Retinal fundus photograph, 1932 by 1916 pixels
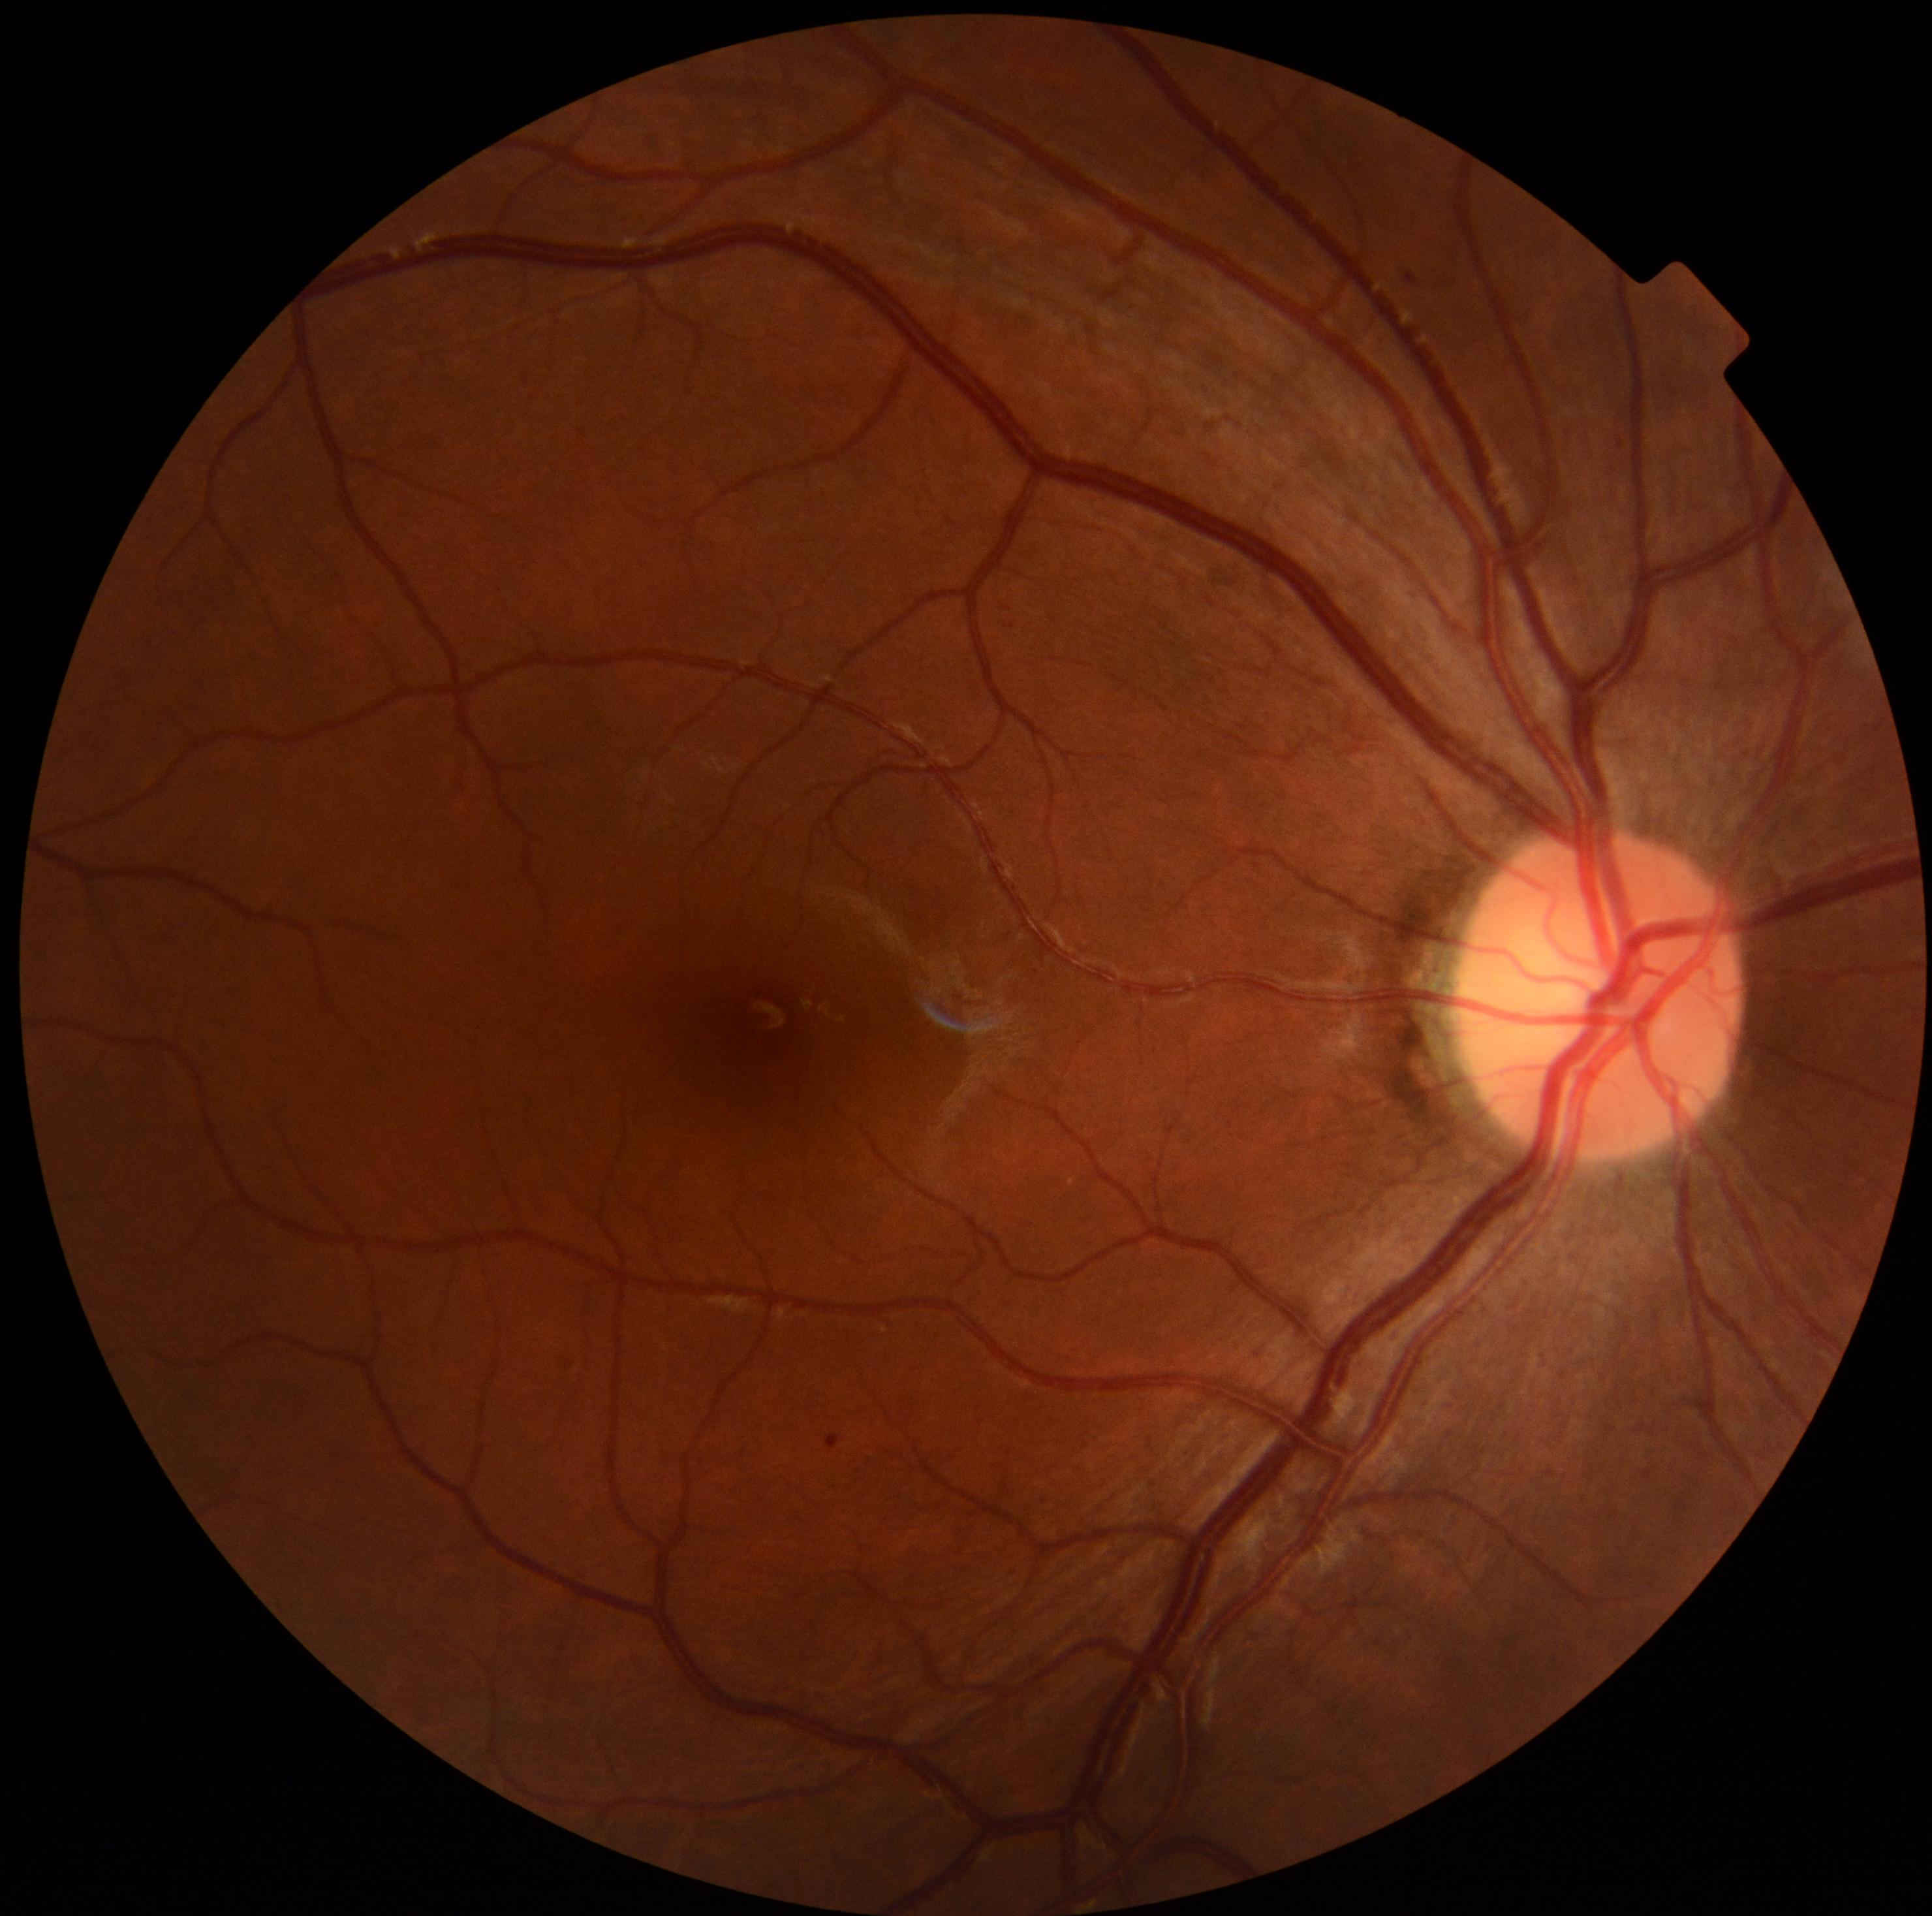
  dr_category: non-proliferative diabetic retinopathy
  dr_grade: 1